2212 x 1659 pixels, retinal fundus photograph
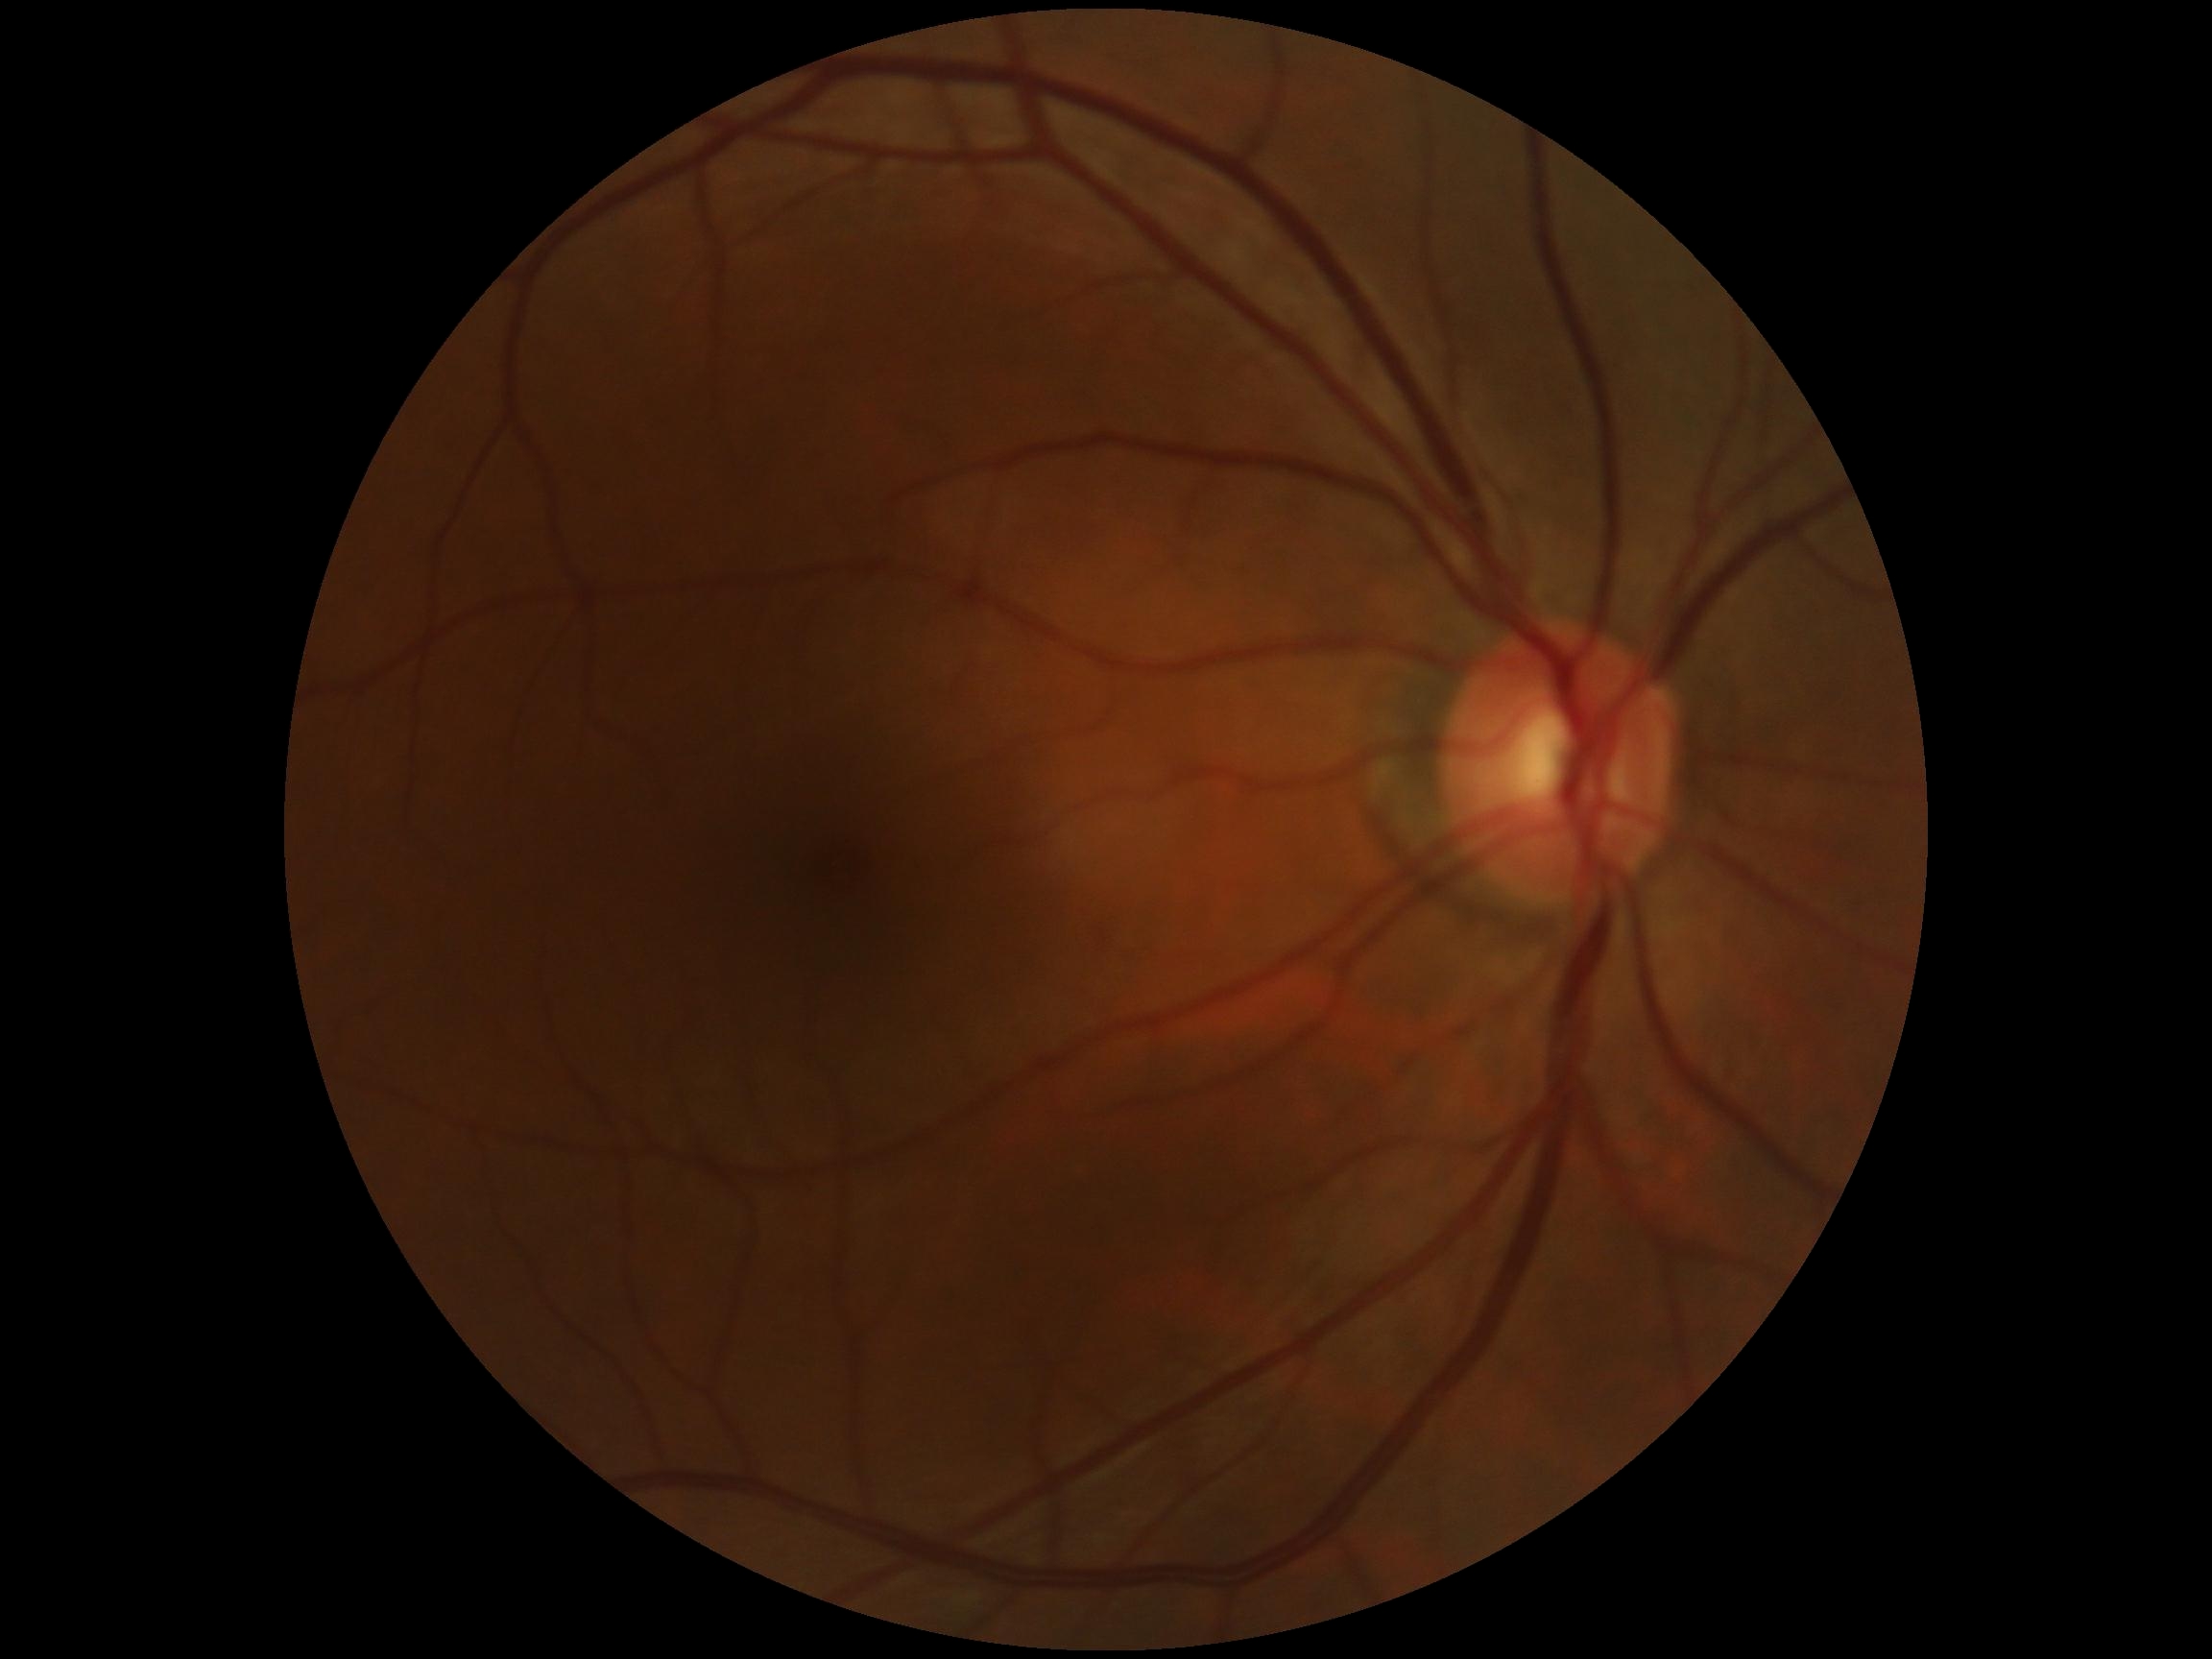 DR severity = grade 0 (no apparent retinopathy).